Pediatric retinal photograph (wide-field):
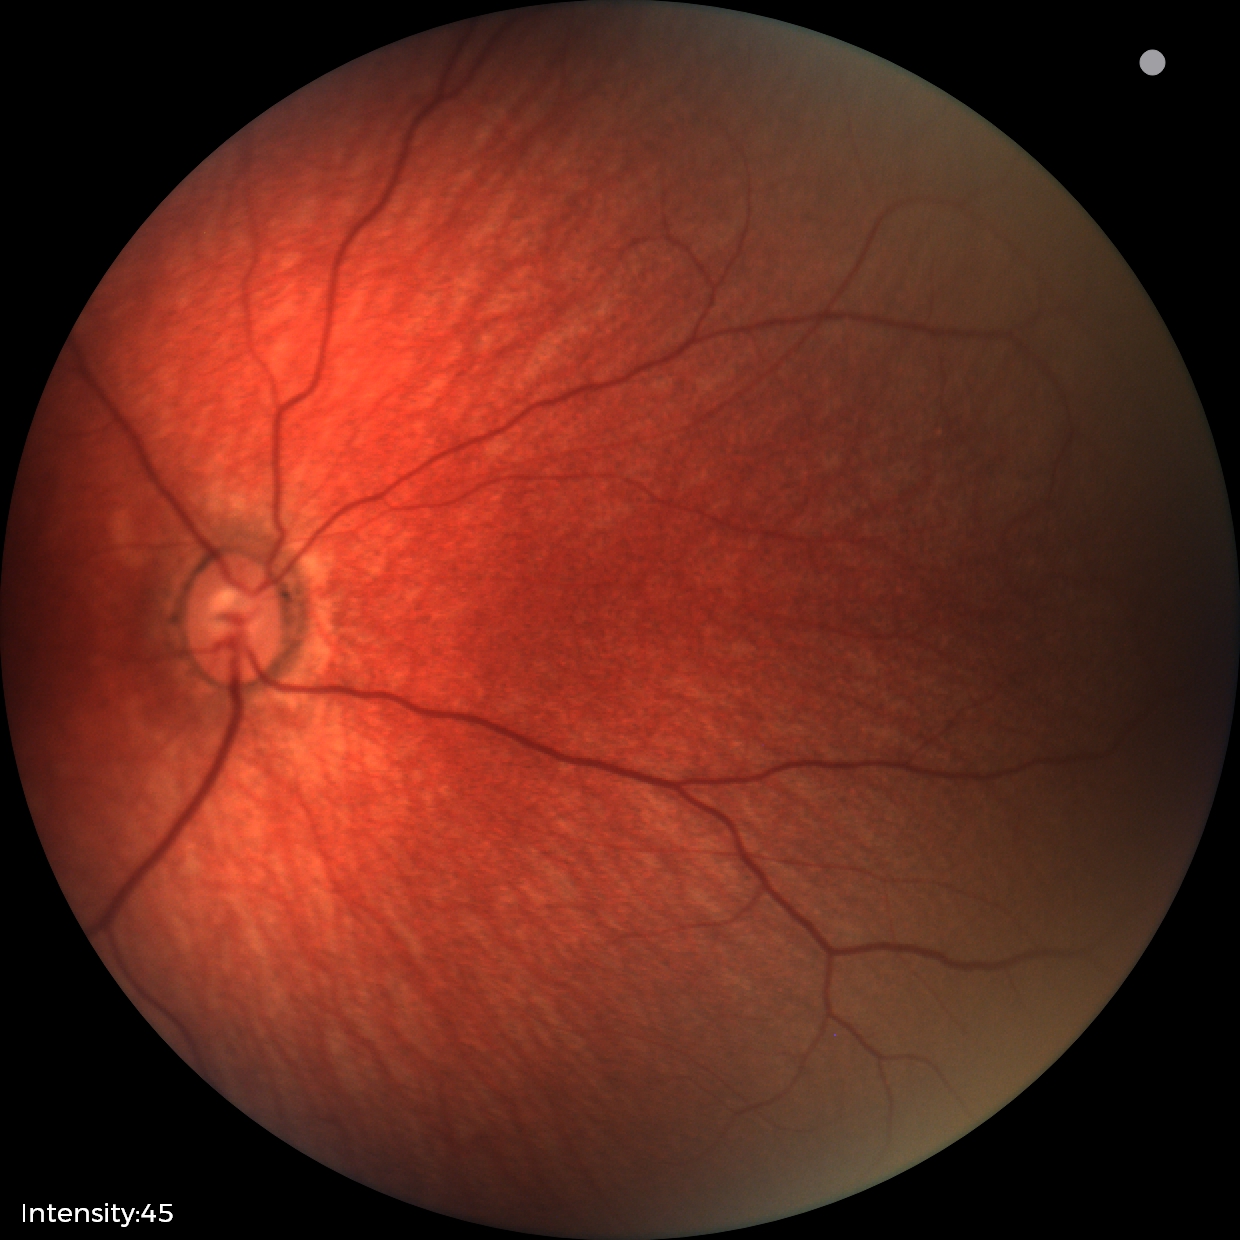

Examination with physiological retinal findings.